Diabetic retinopathy graded by the modified Davis classification; 45° field of view — 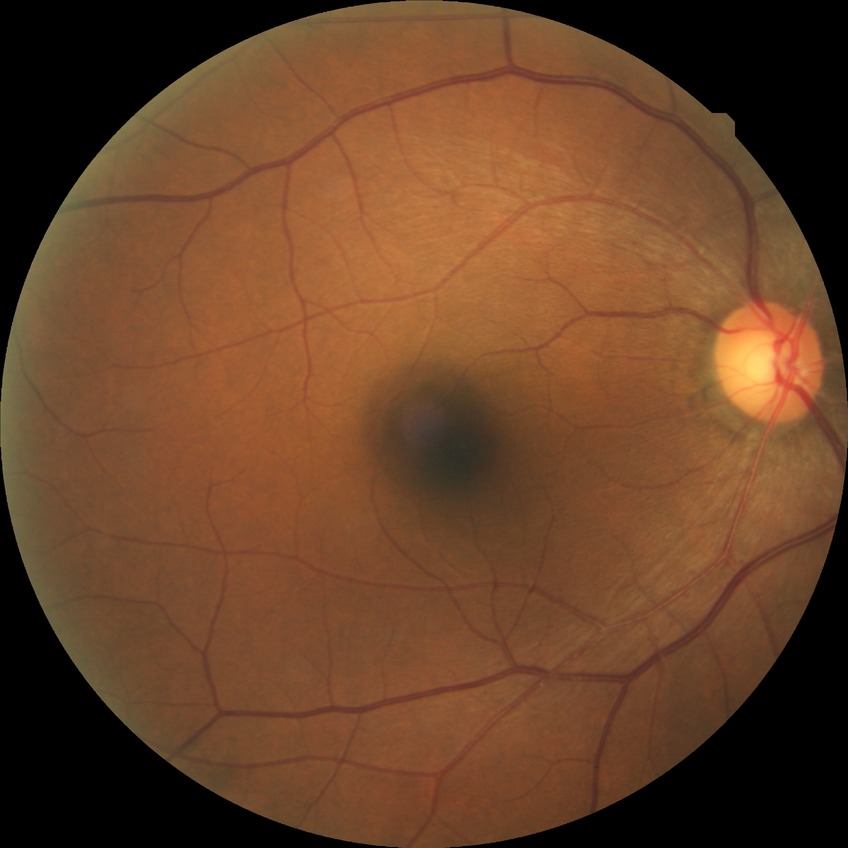

diabetic retinopathy (DR)=no diabetic retinopathy (NDR).